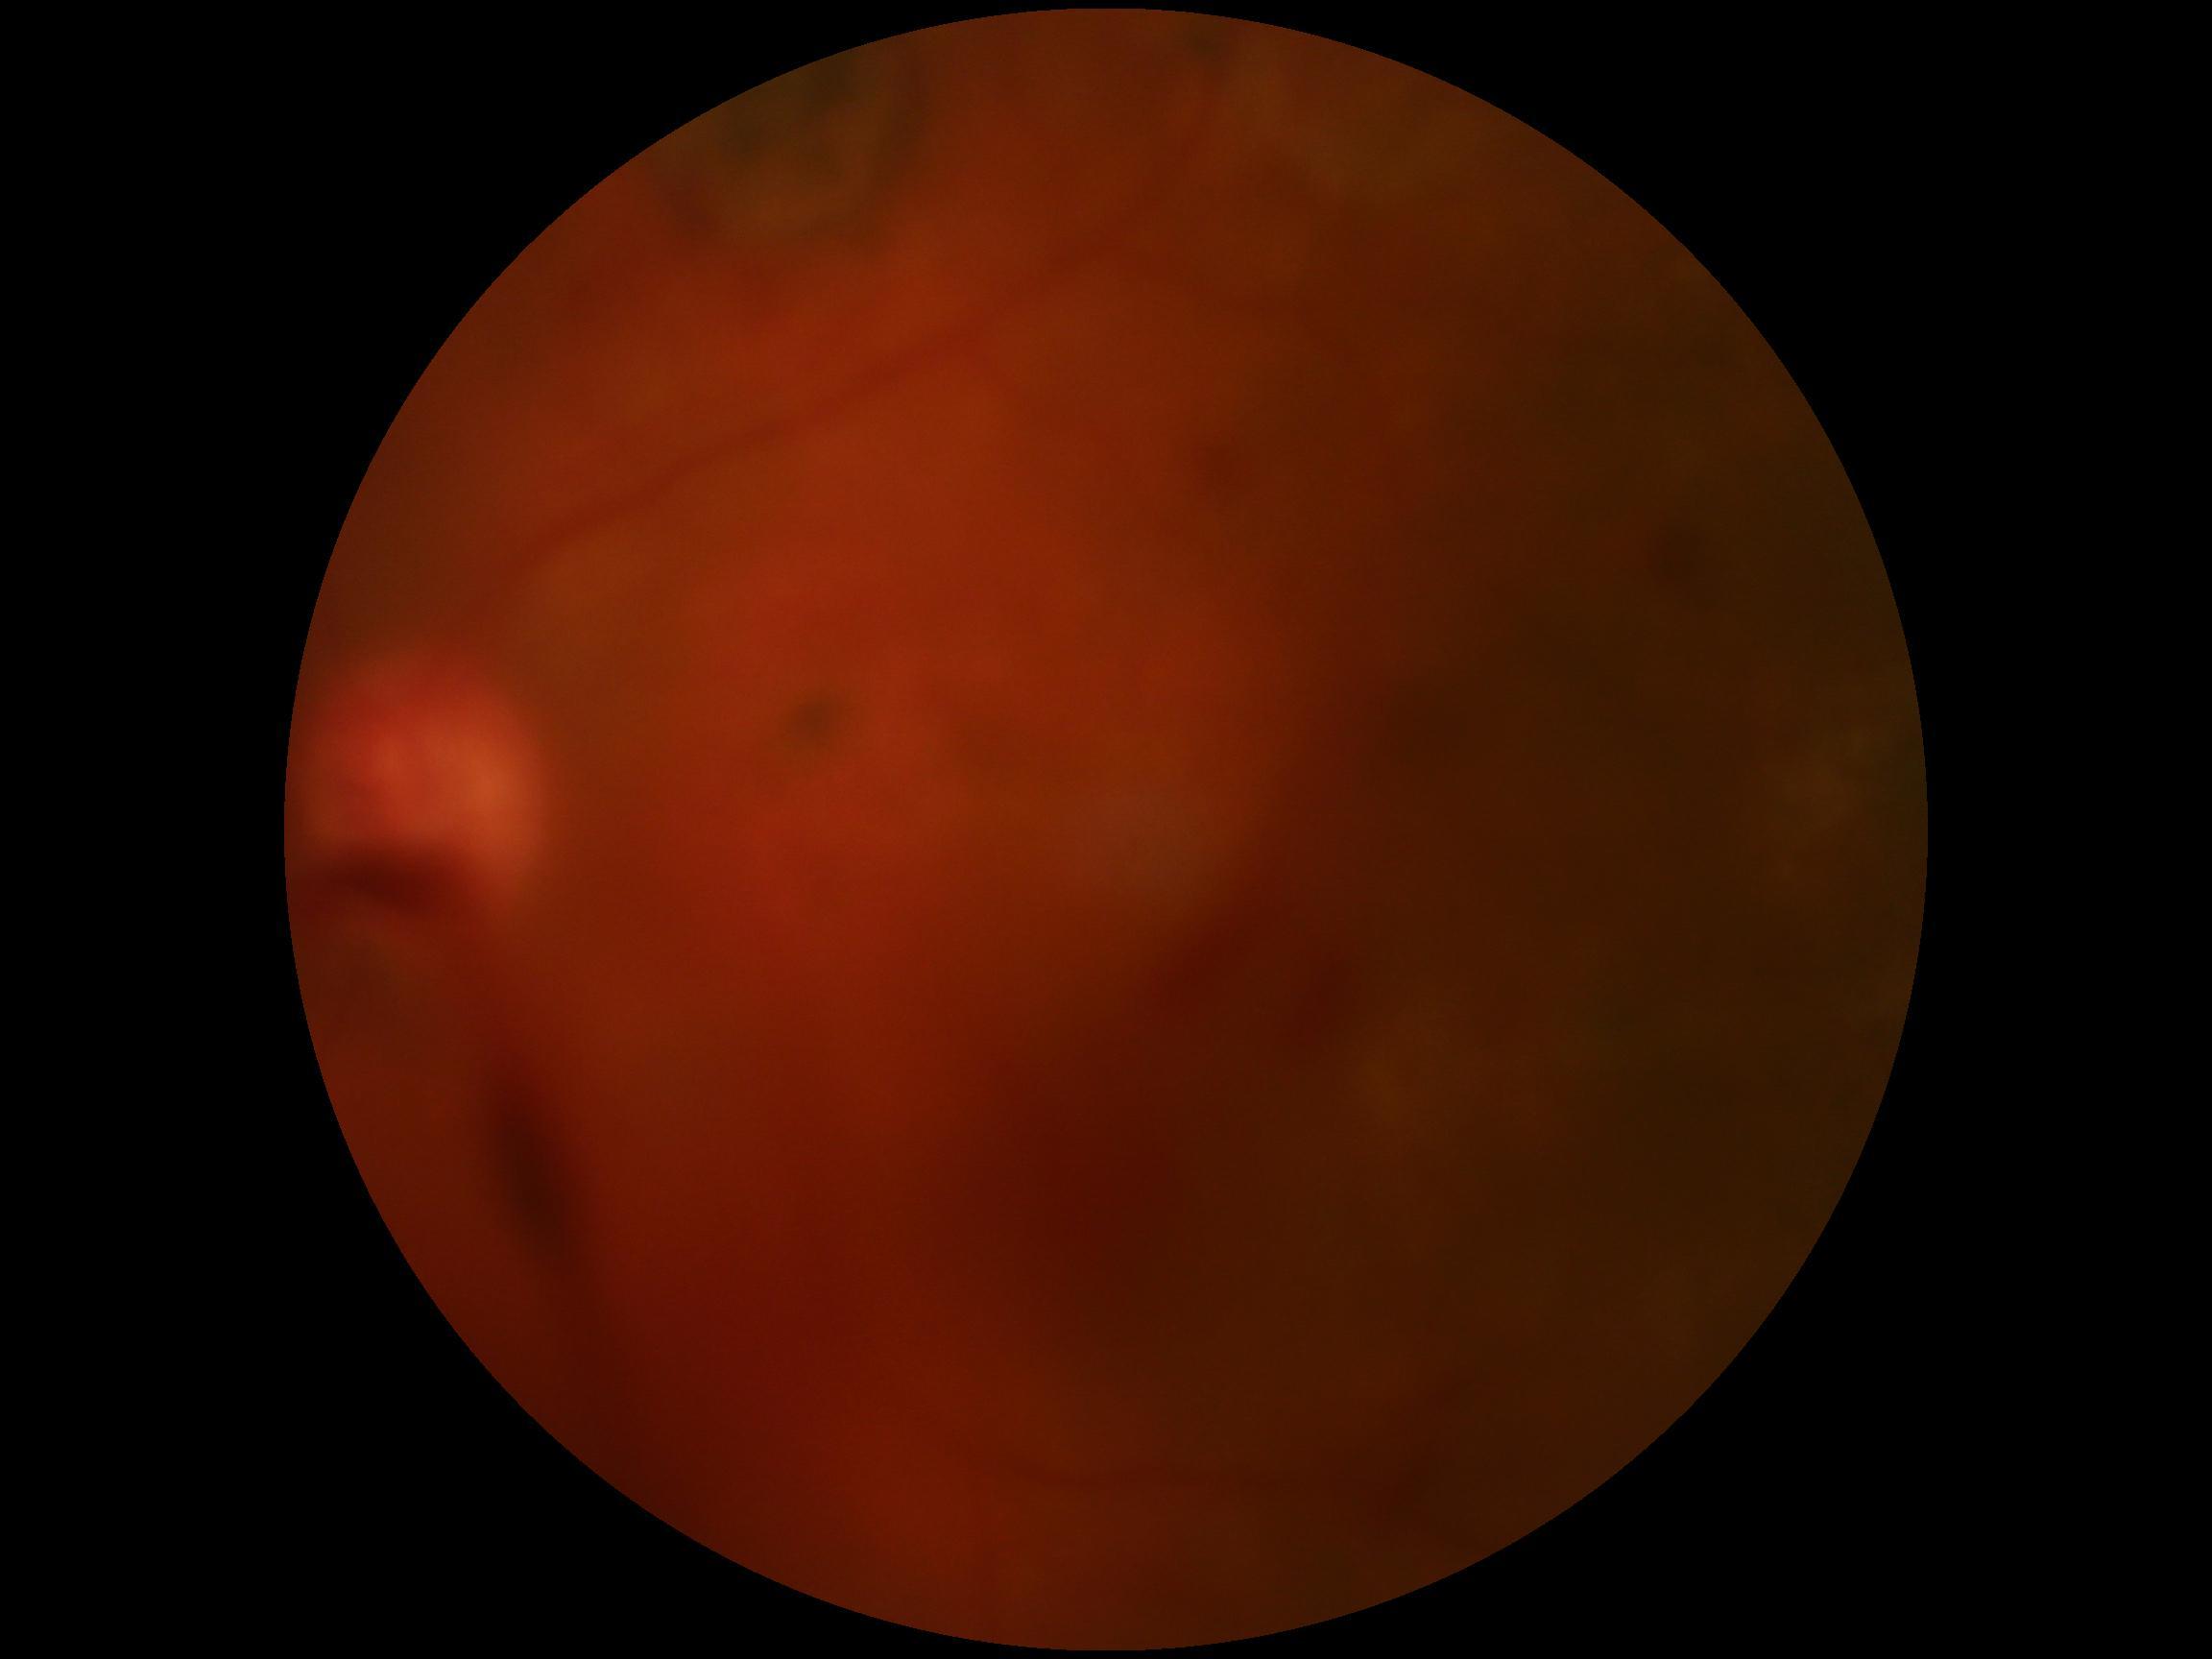
diabetic retinopathy grade@4 (PDR) — neovascularization and/or vitreous/pre-retinal hemorrhage.